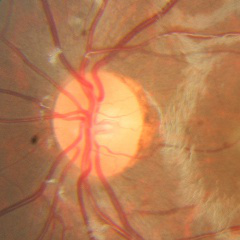
No glaucoma.